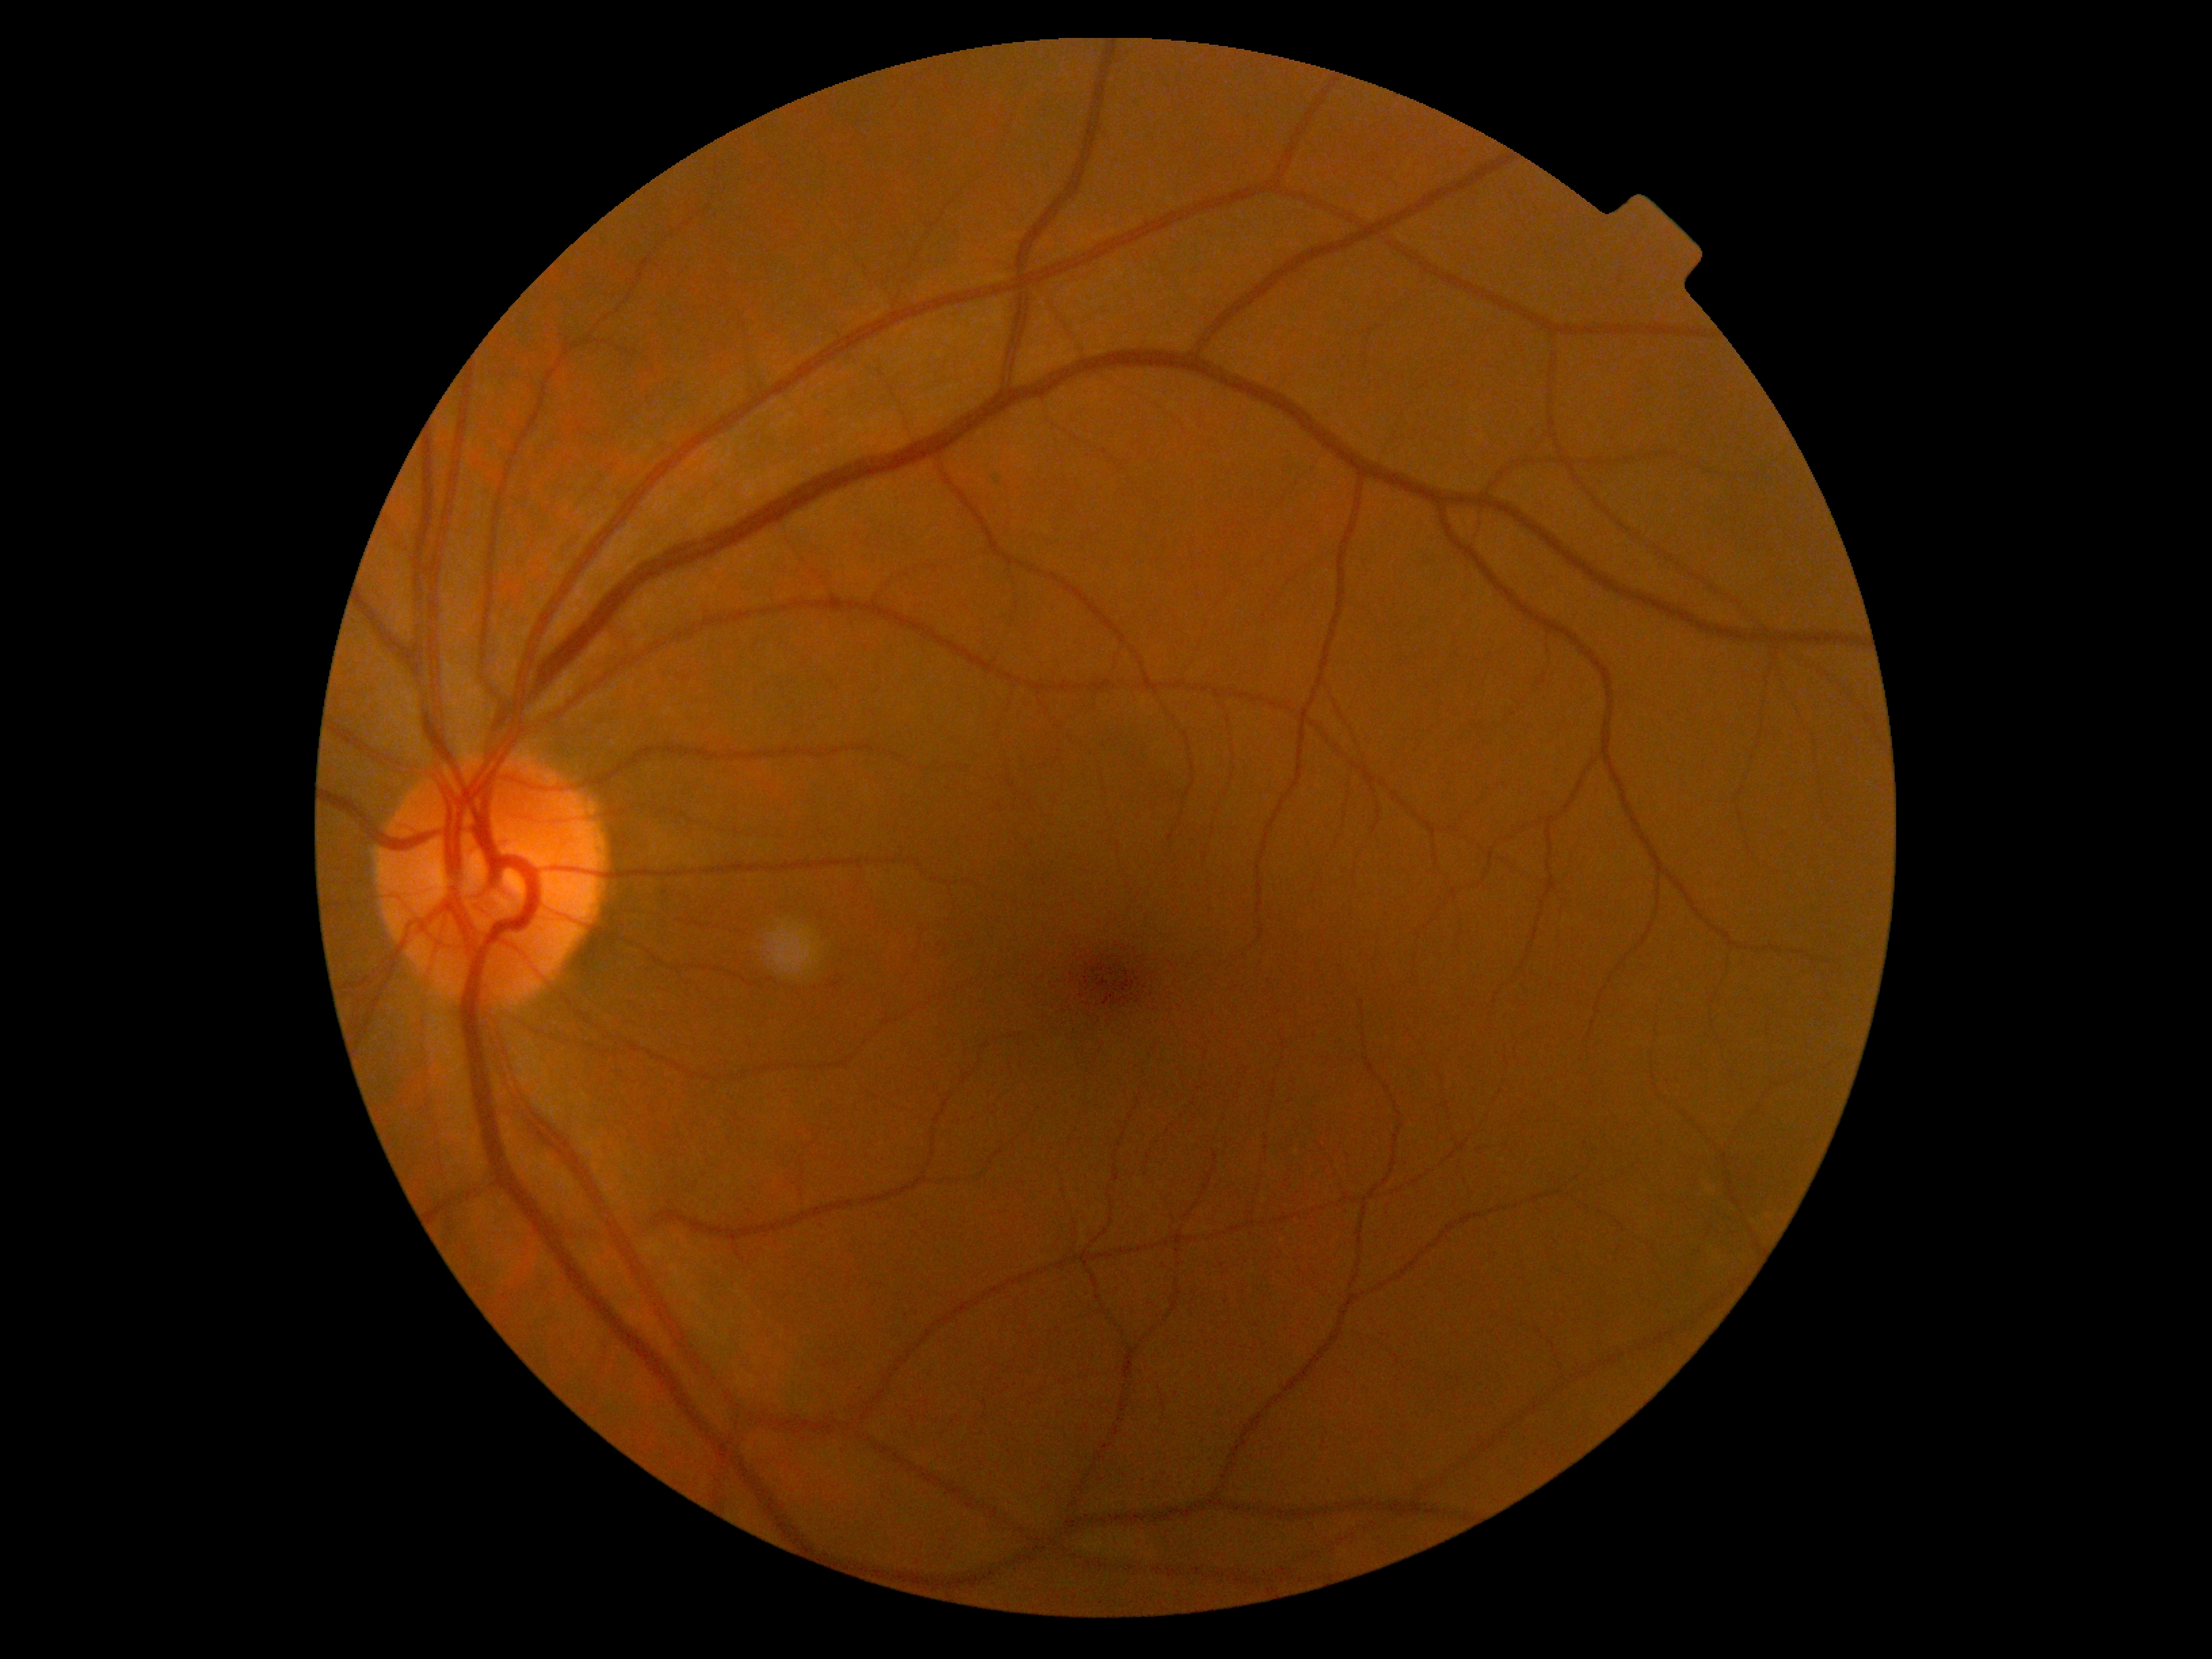

DR stage is 0/4.